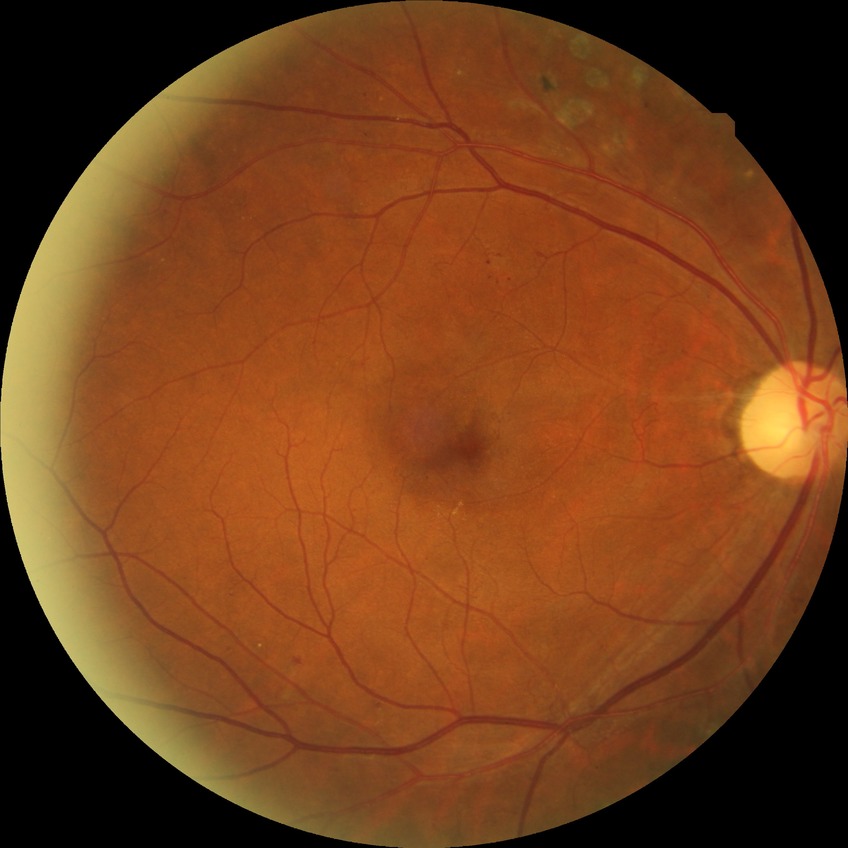 Davis DR grade: PPDR.